Color fundus image: 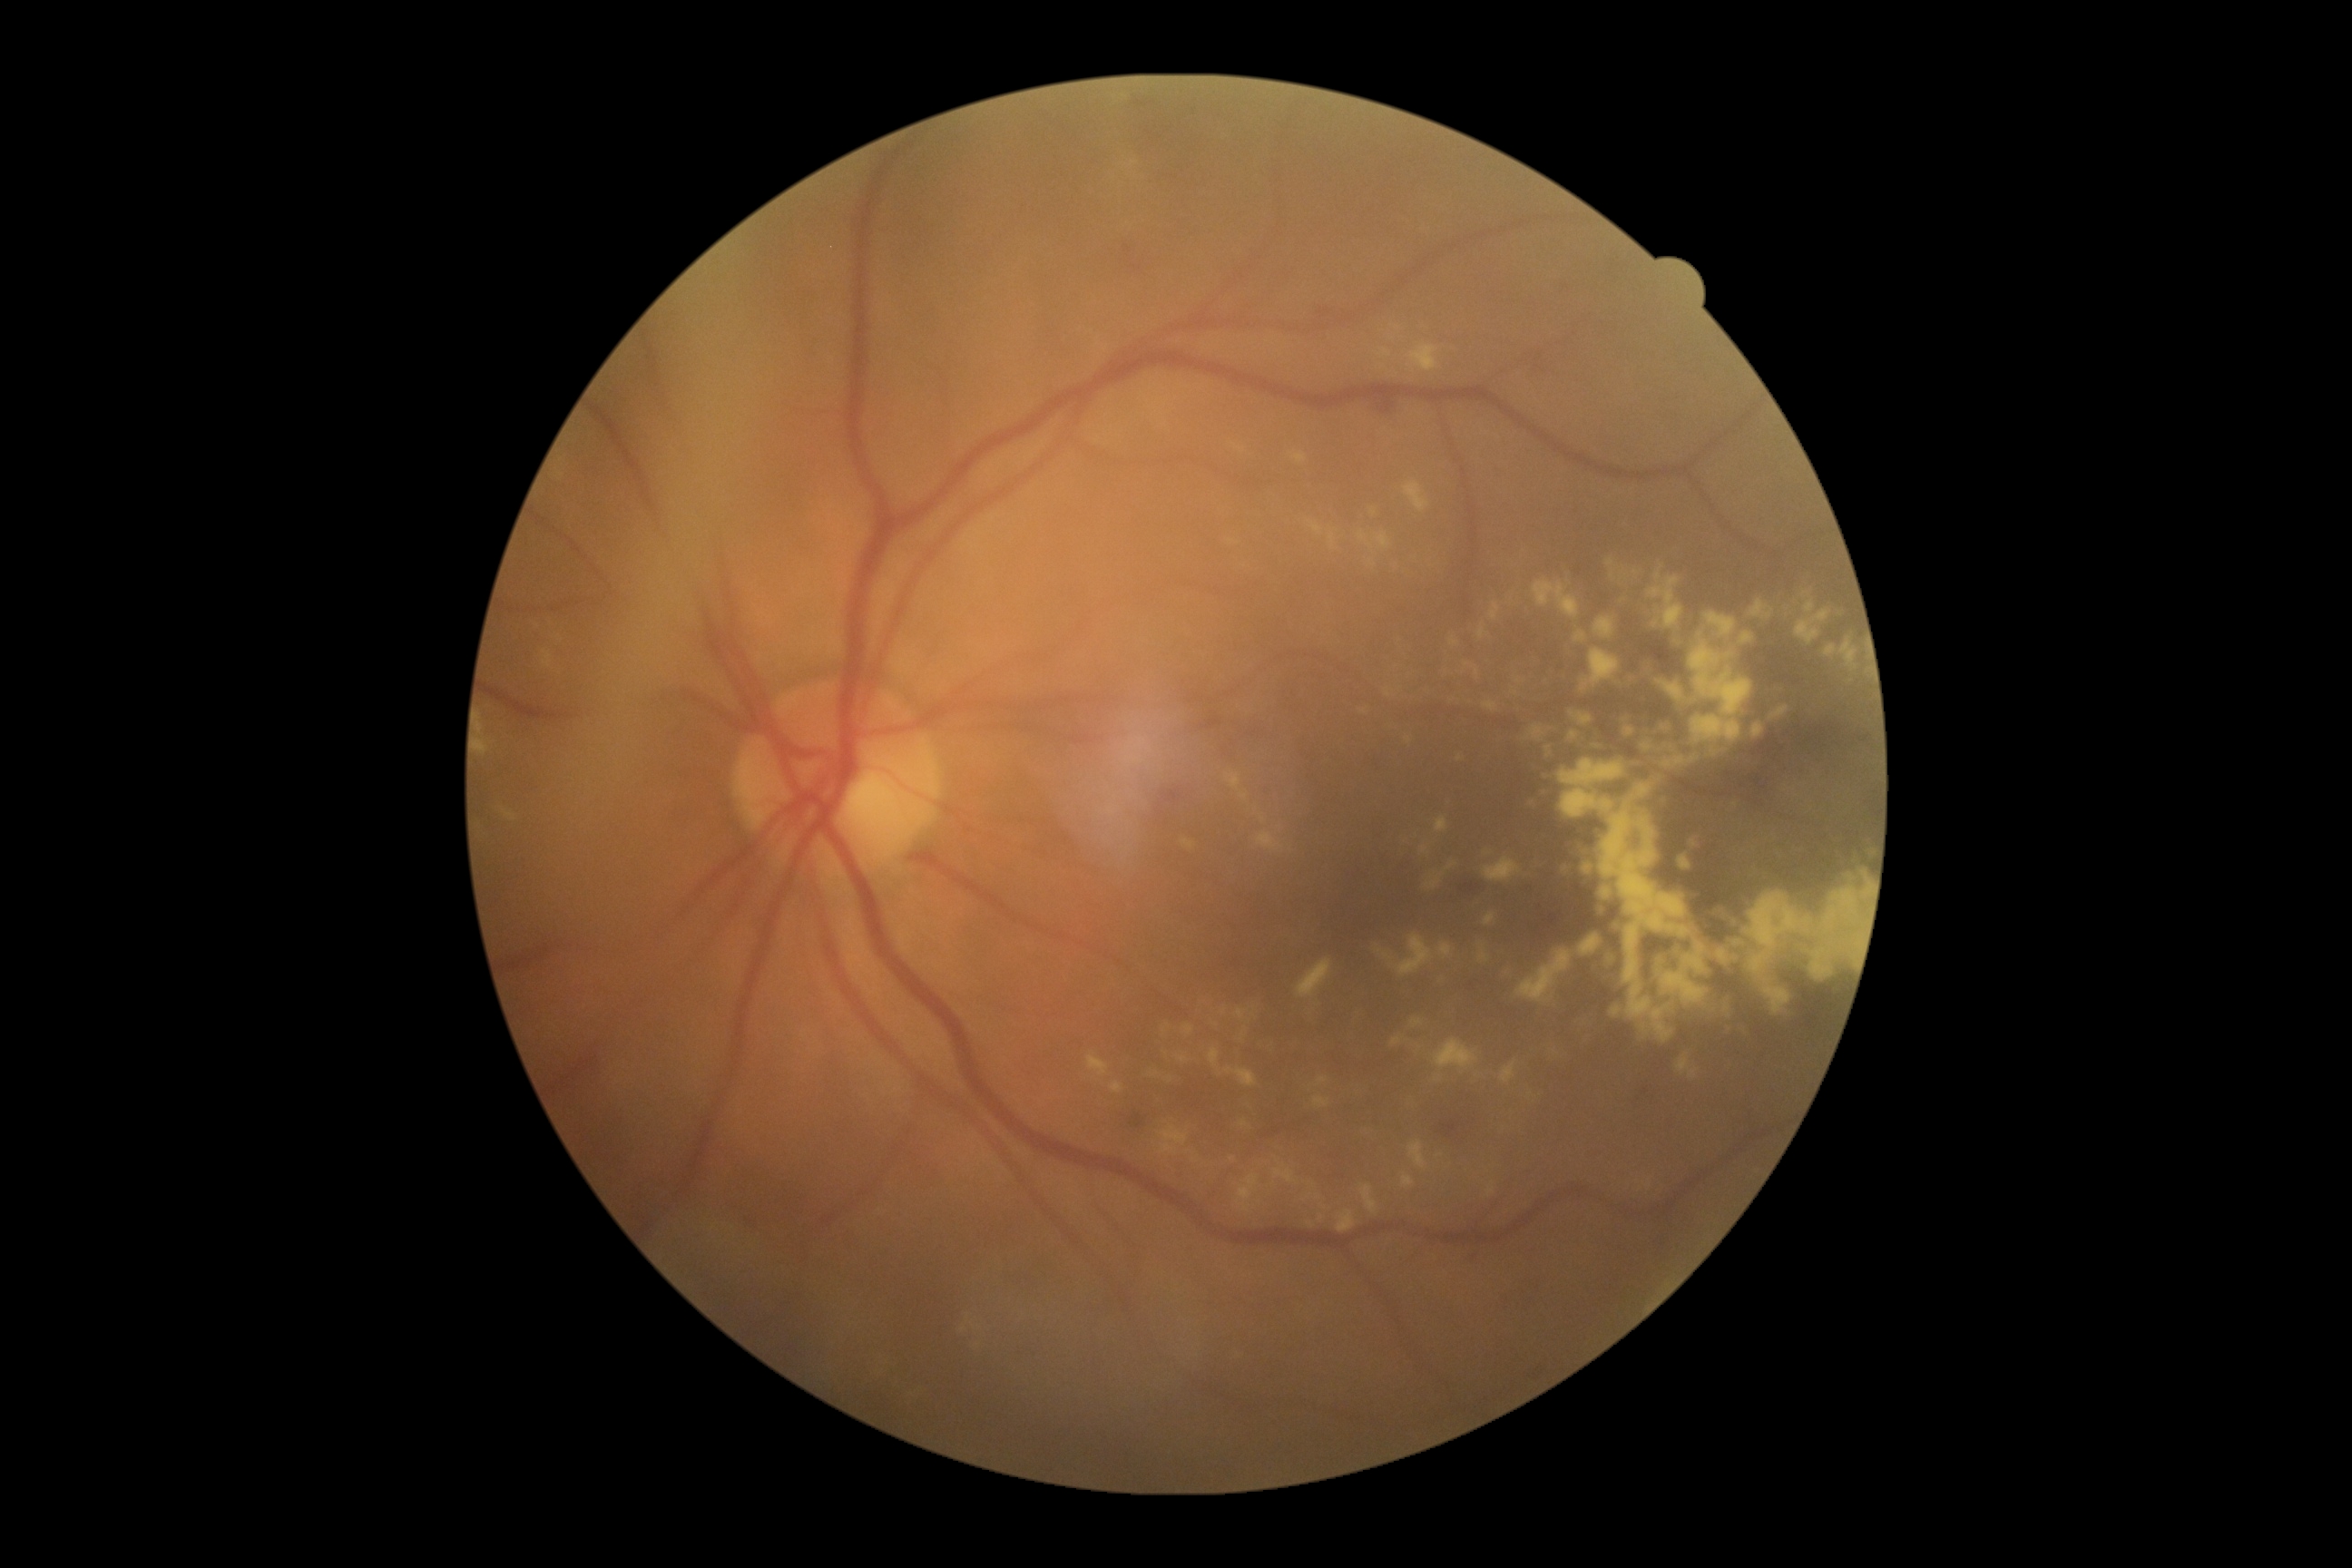 Diabetic retinopathy grade: 2/4. Disease class: non-proliferative diabetic retinopathy.